Color fundus photograph, image size 2352x1568, 45-degree field of view.
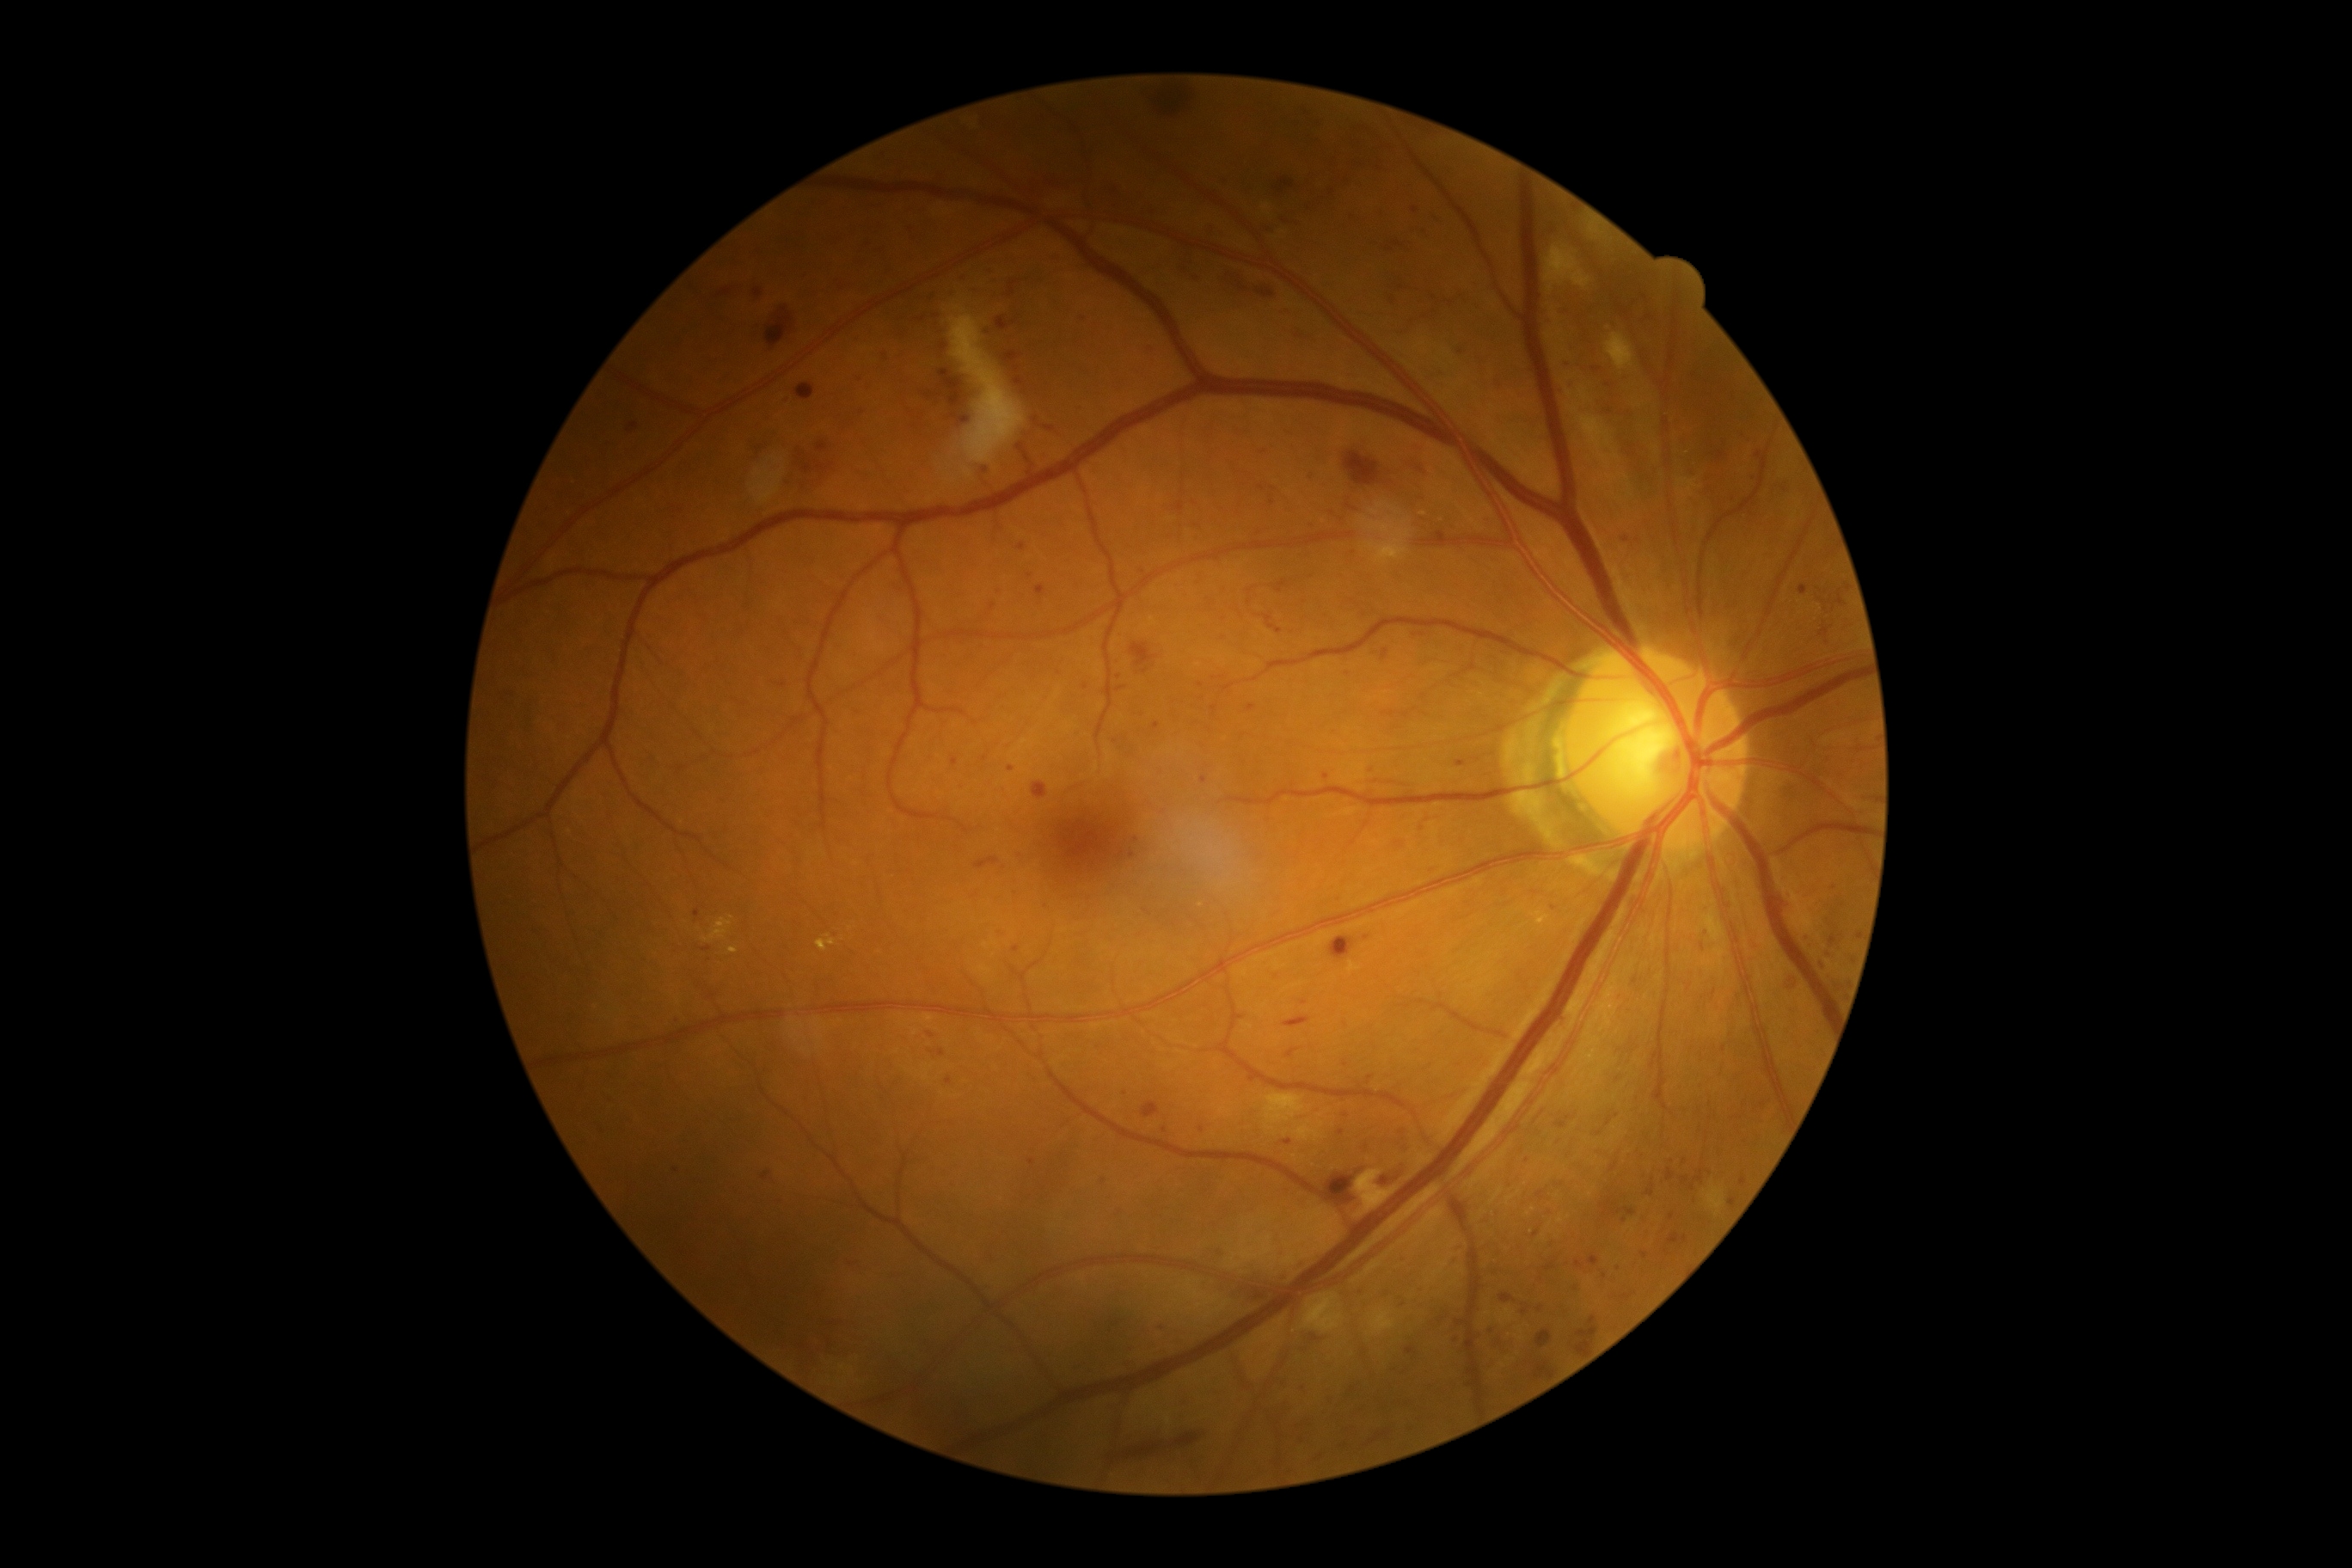

DR stage: 3/4.